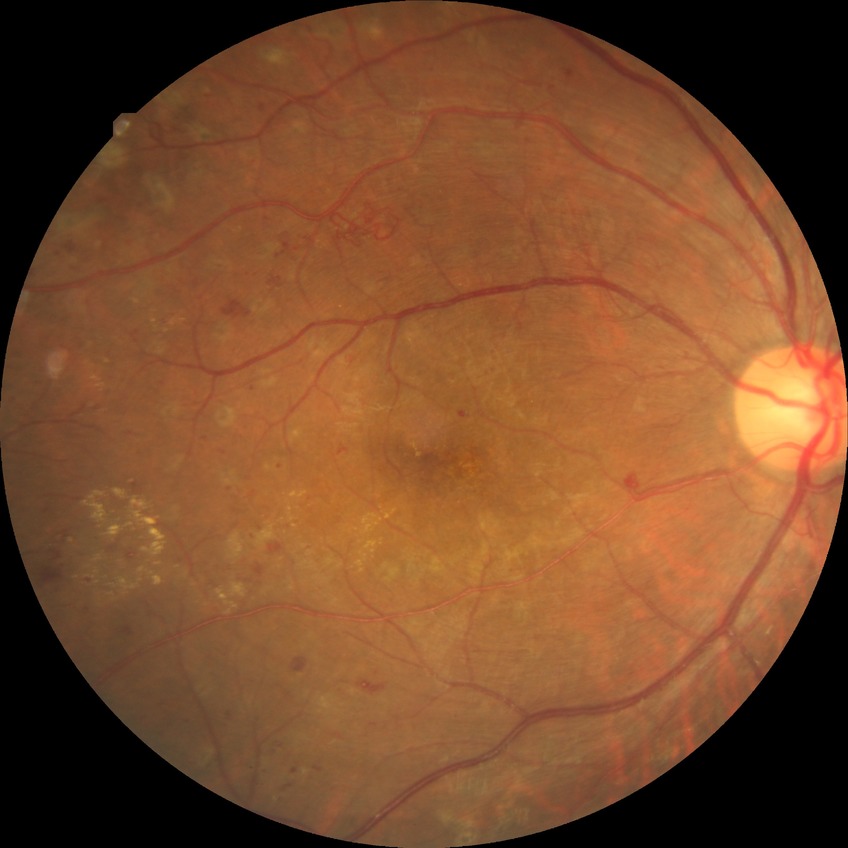
modified Davis grade = PDR.